CFP: 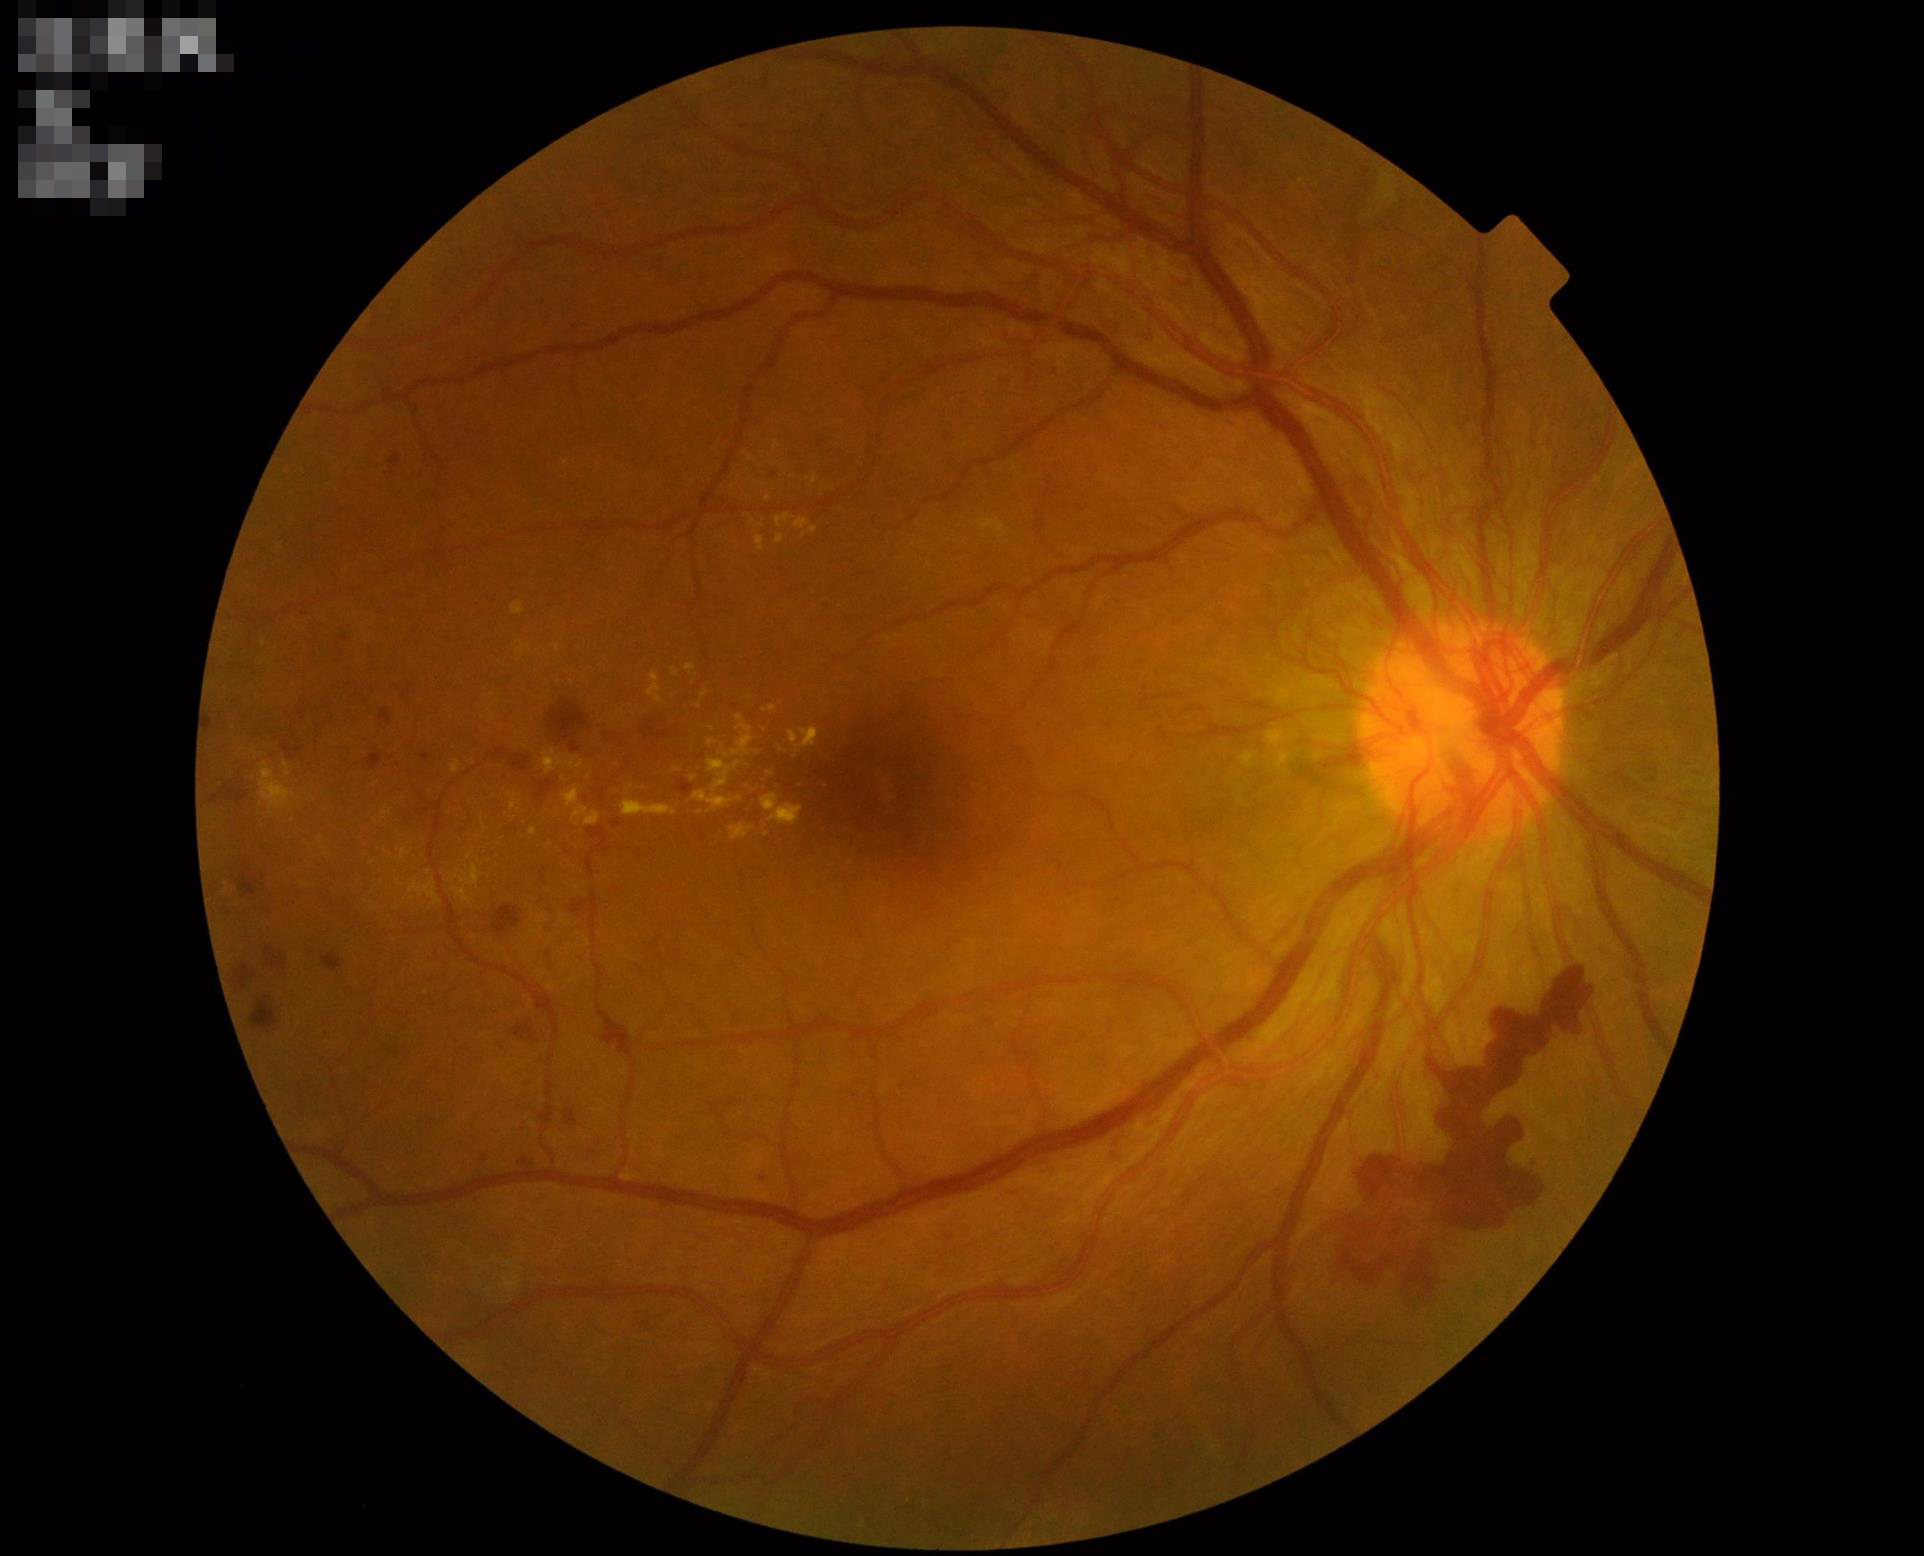

Illumination = satisfactory; Overall image quality = acceptable; Contrast = satisfactory; Clarity = in focus.